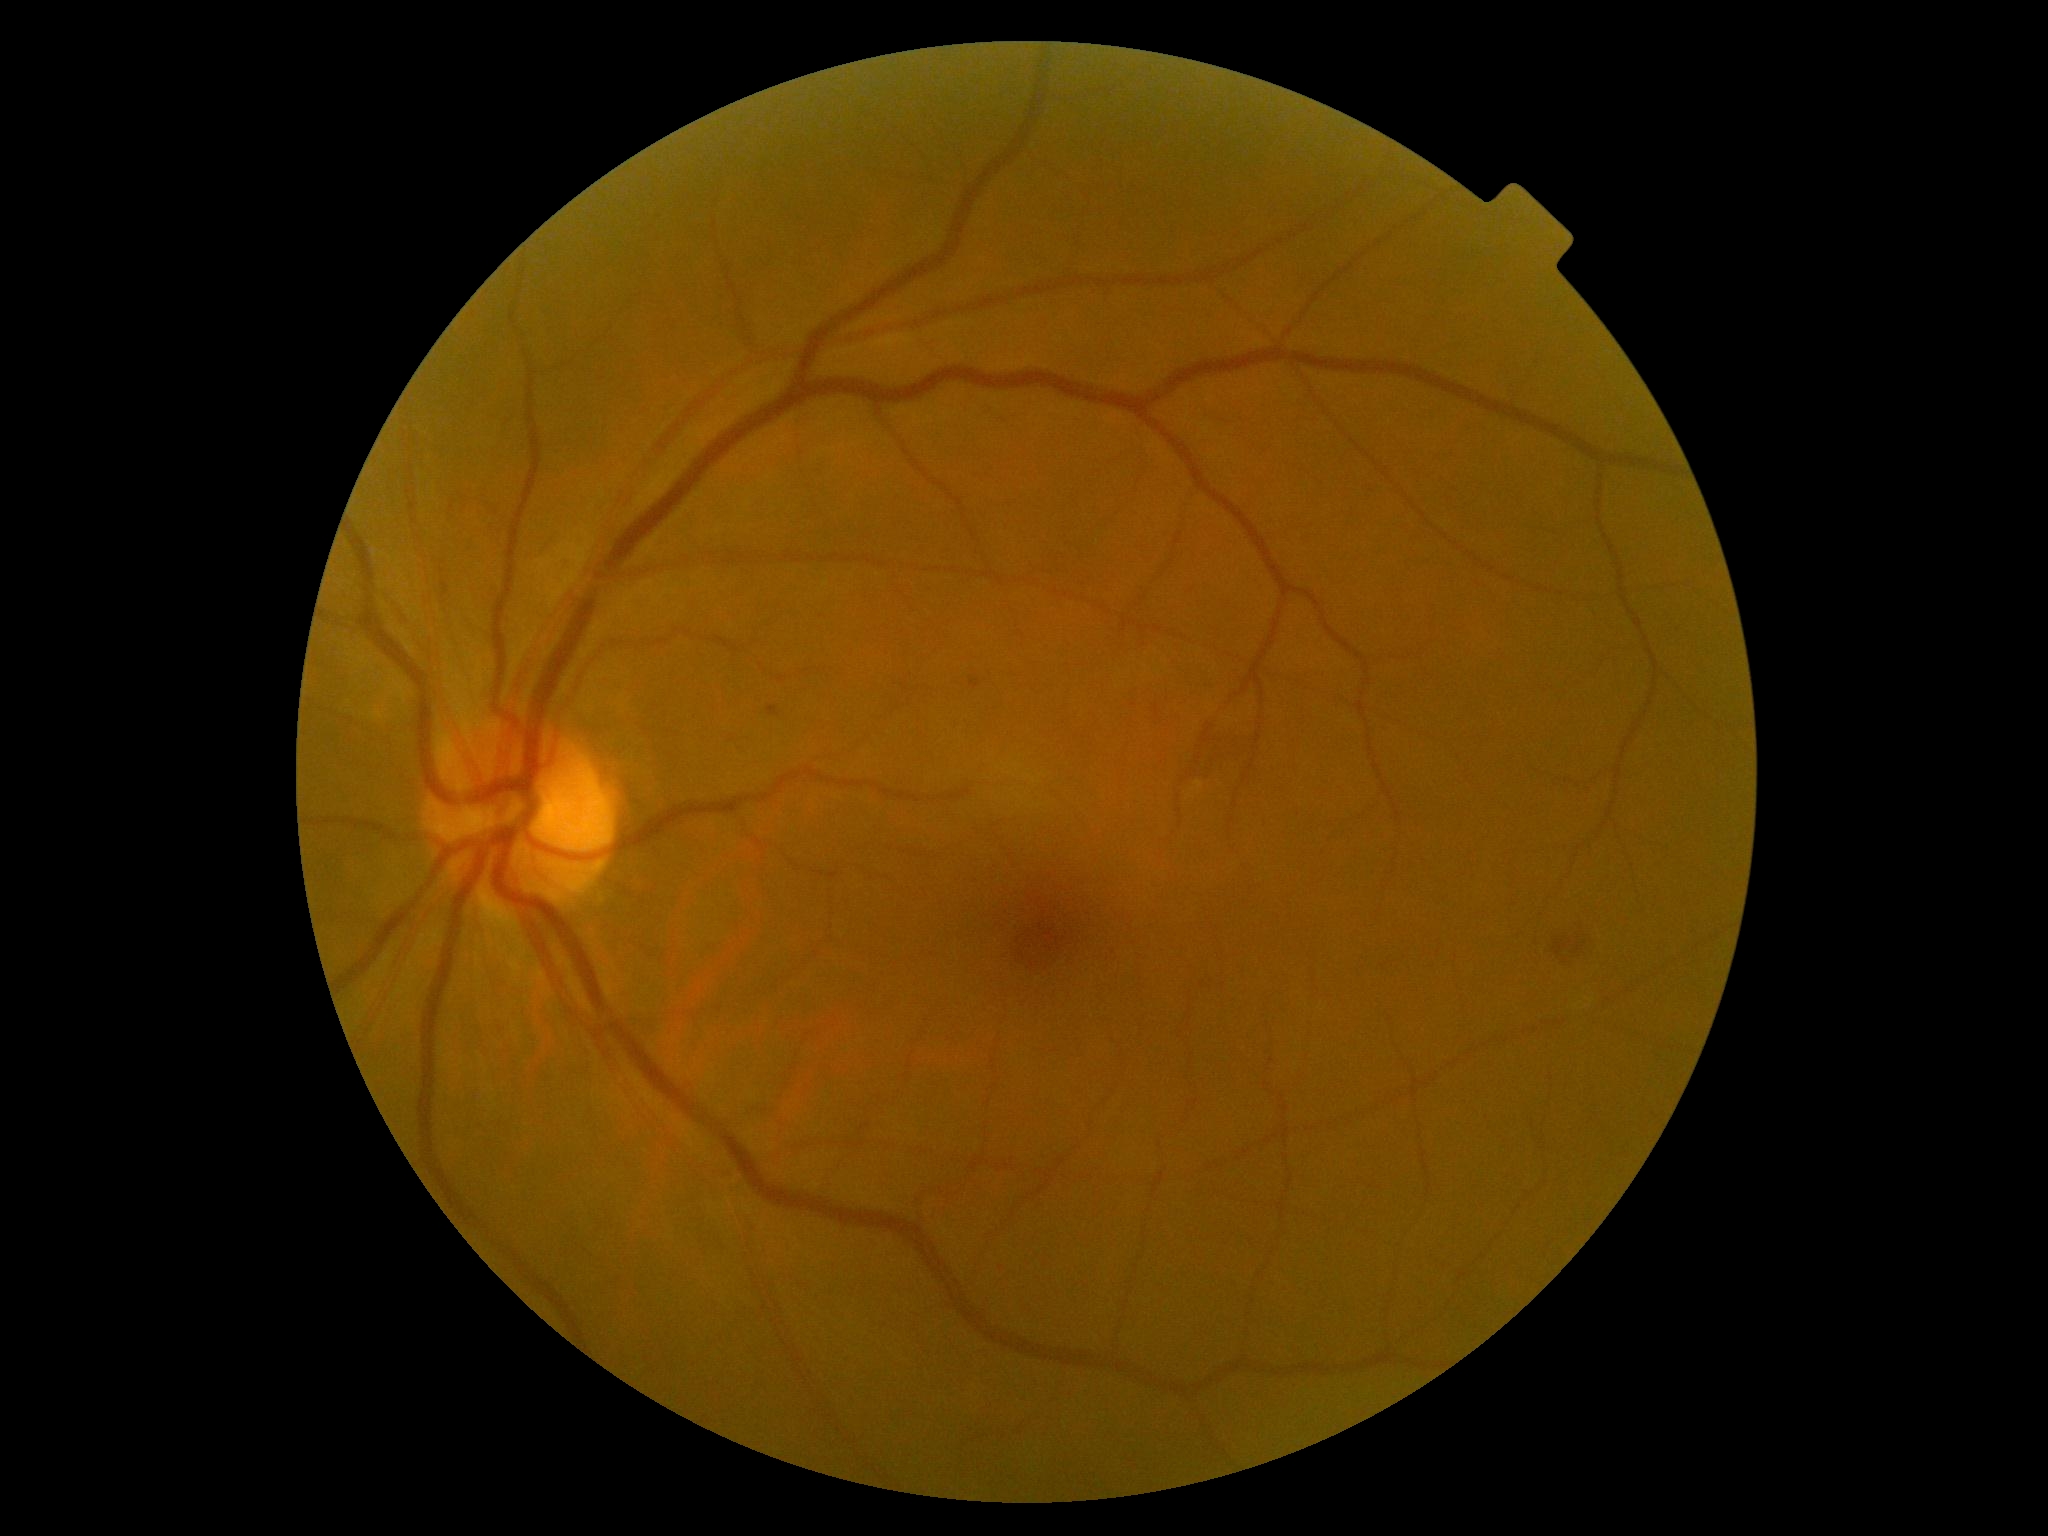

DR is 2.